Nonmydriatic; NIDEK AFC-230: 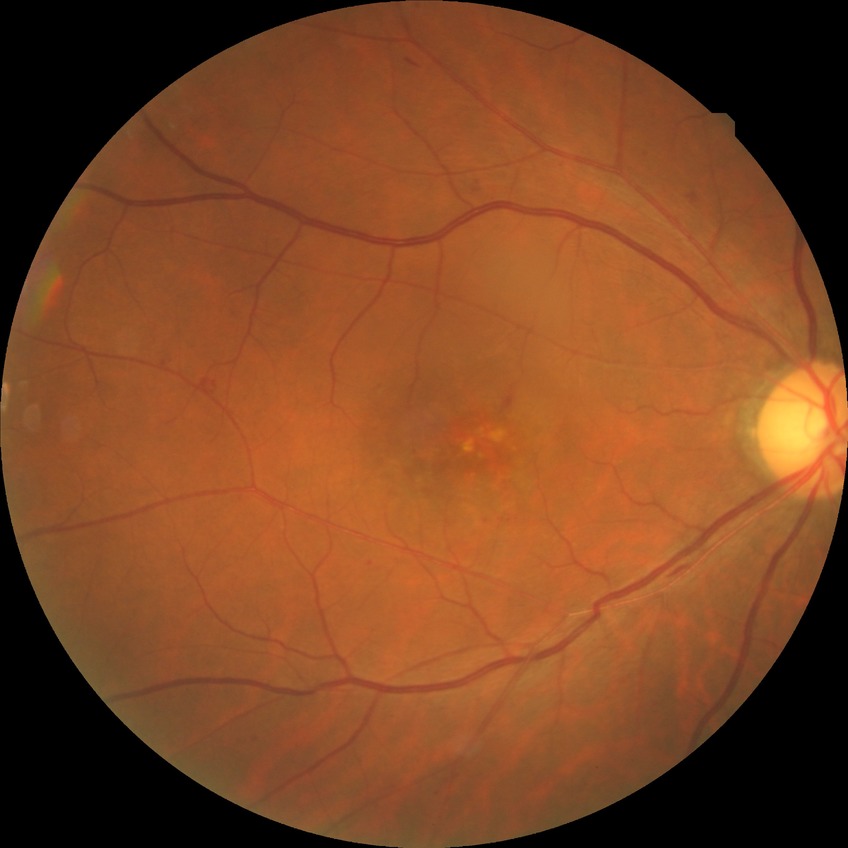

Diabetic retinopathy (DR): simple diabetic retinopathy (SDR).